RetCam wide-field infant fundus image. 130° field of view (Clarity RetCam 3). 640x480 — 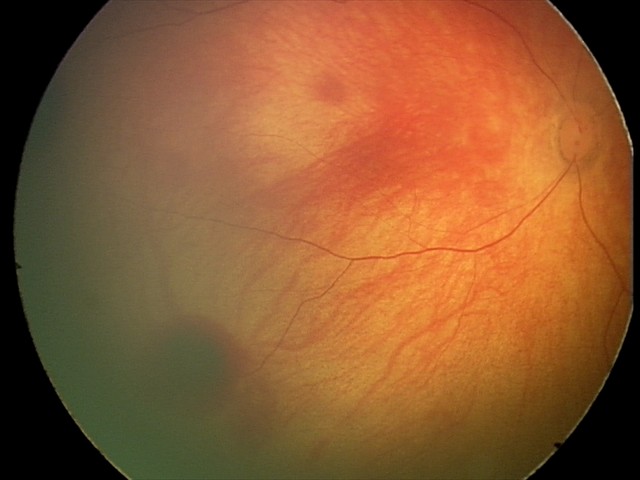

Screening diagnosis: retinal hemorrhages.